Wide-field fundus photograph of an infant · 1240x1240px.
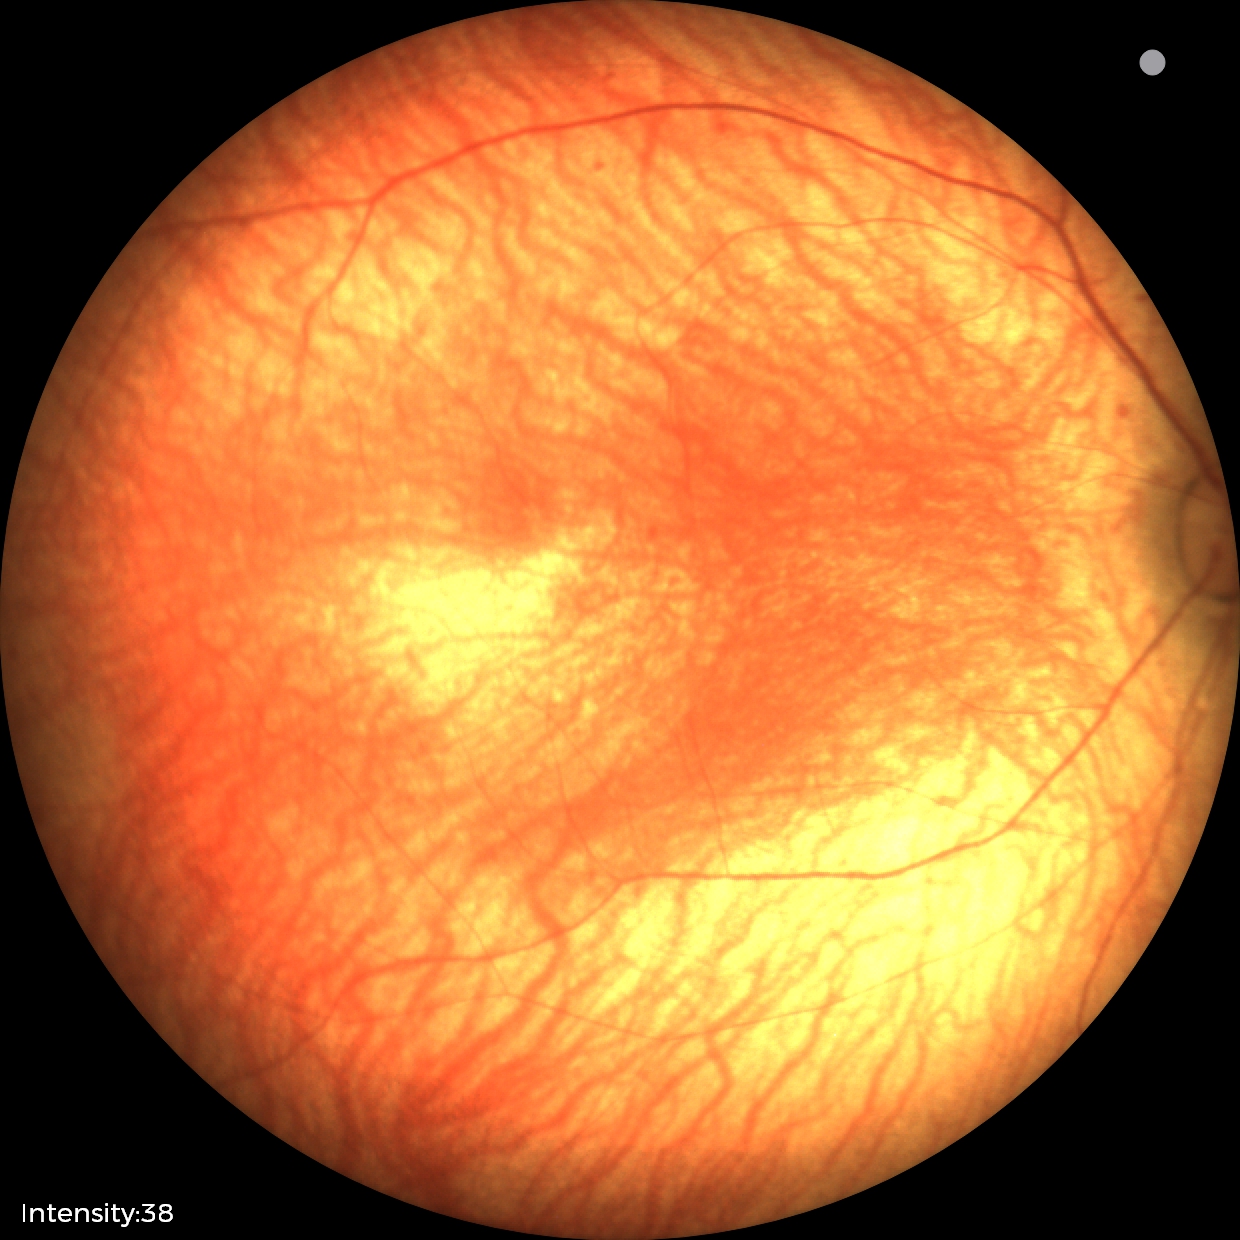

No retinal pathology identified on screening.